Color fundus photograph · 45-degree field of view · 1725 x 1721 pixels:
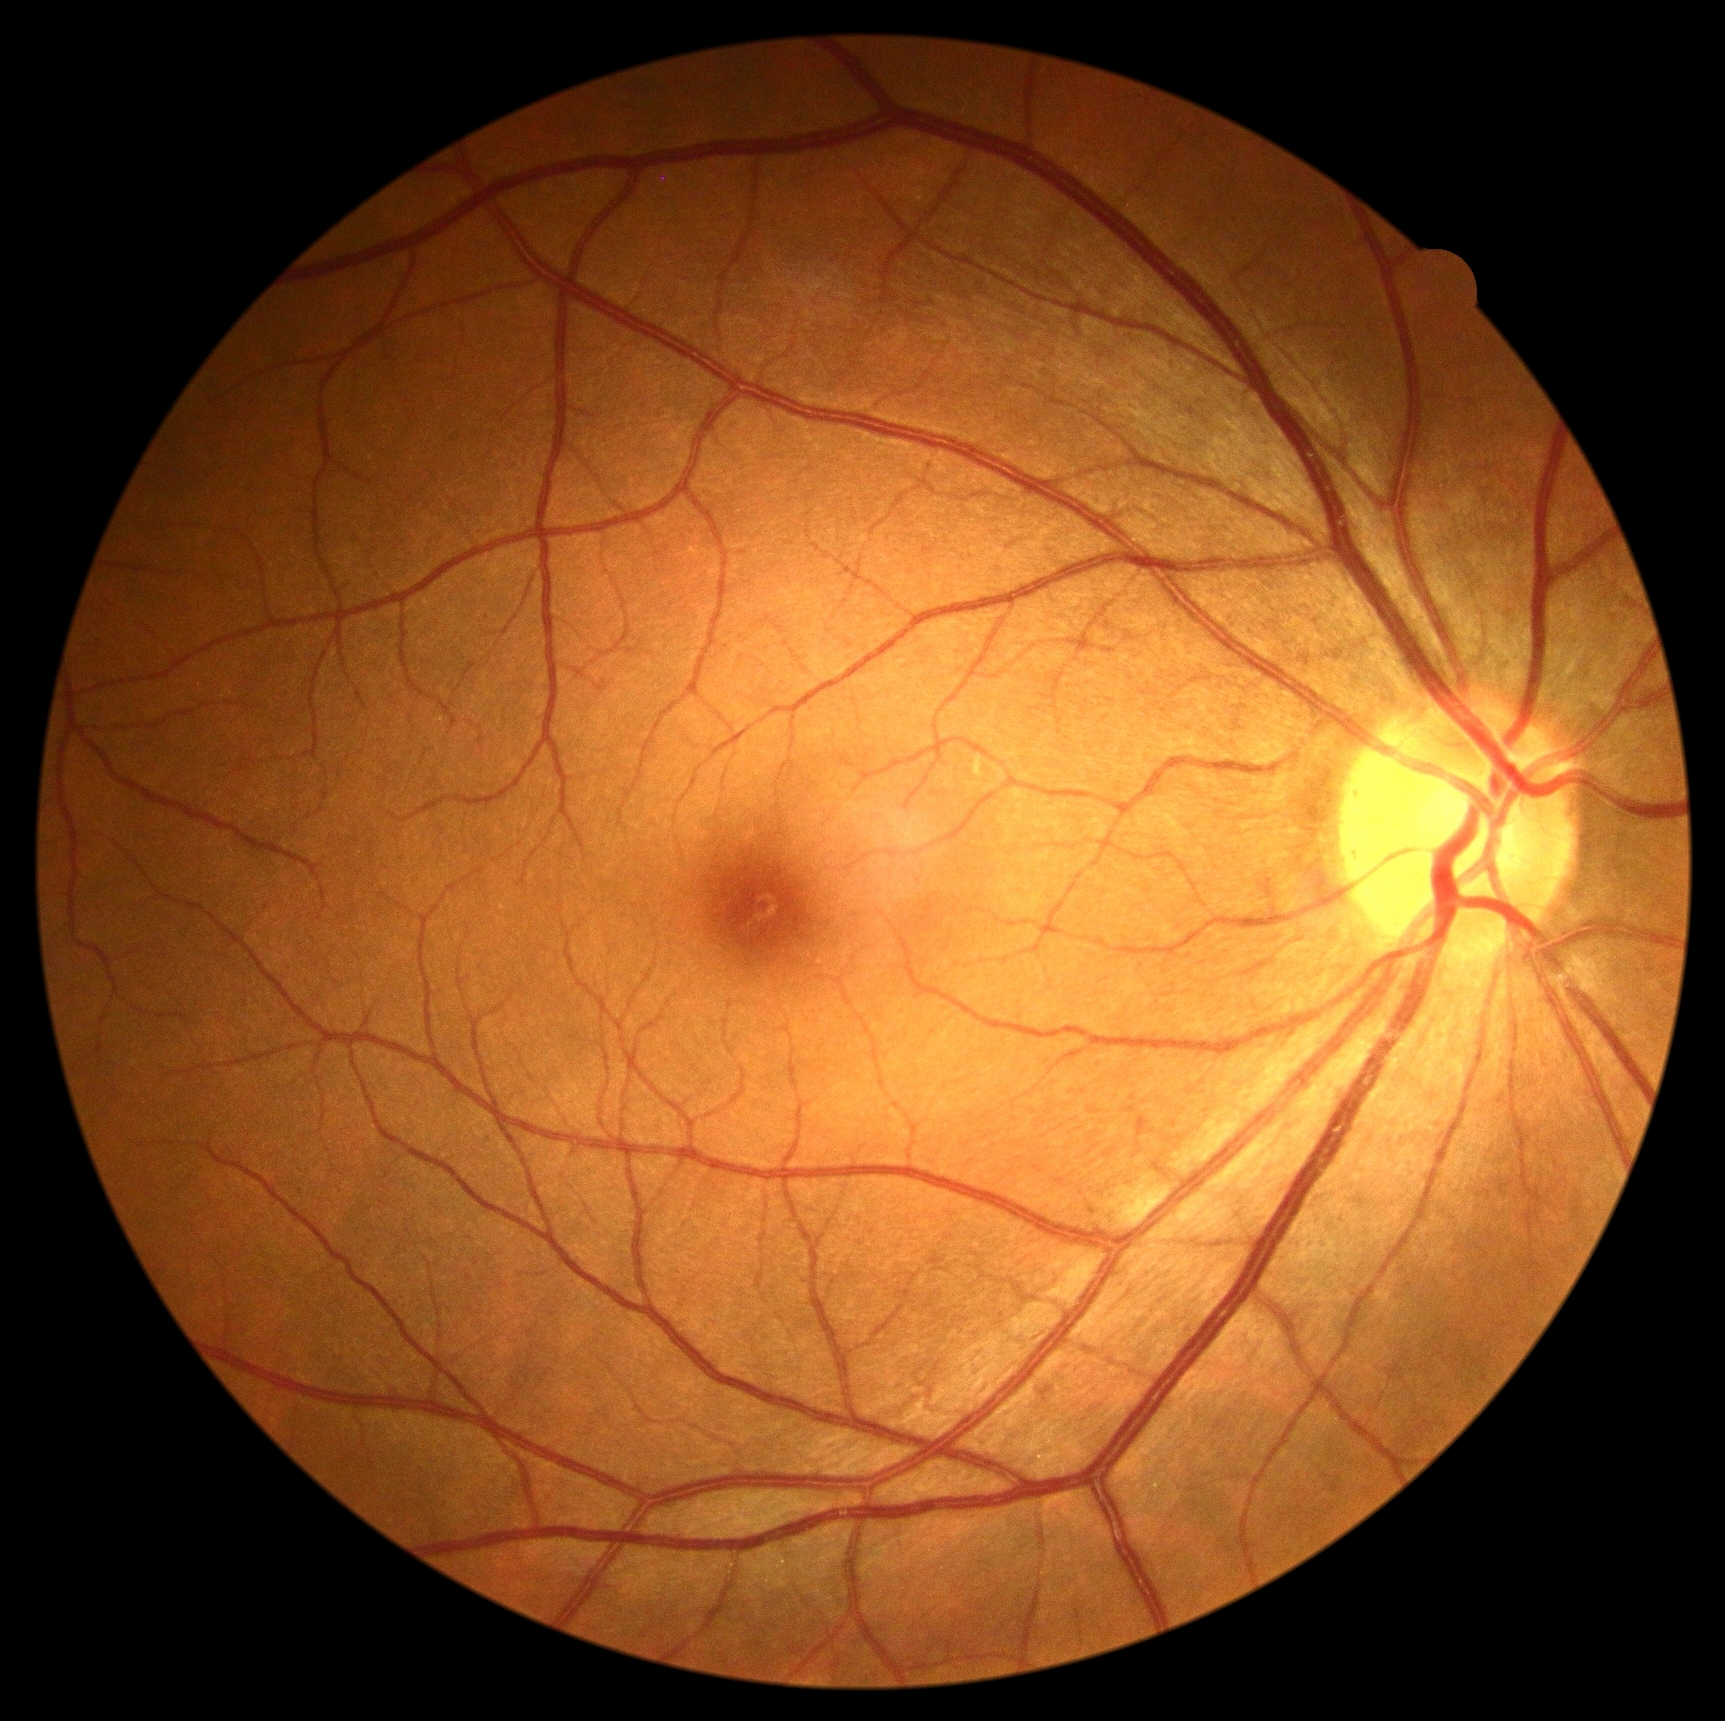
{"dr_grade": "grade 0", "dr_impression": "no DR findings"}